Age 42 · centered on the optic disc · axial length (AL): 24 mm · 30-degree field of view · color fundus image · non-mydriatic · corneal thickness 534 µm · acquired with a Topcon TRC-NW400 — 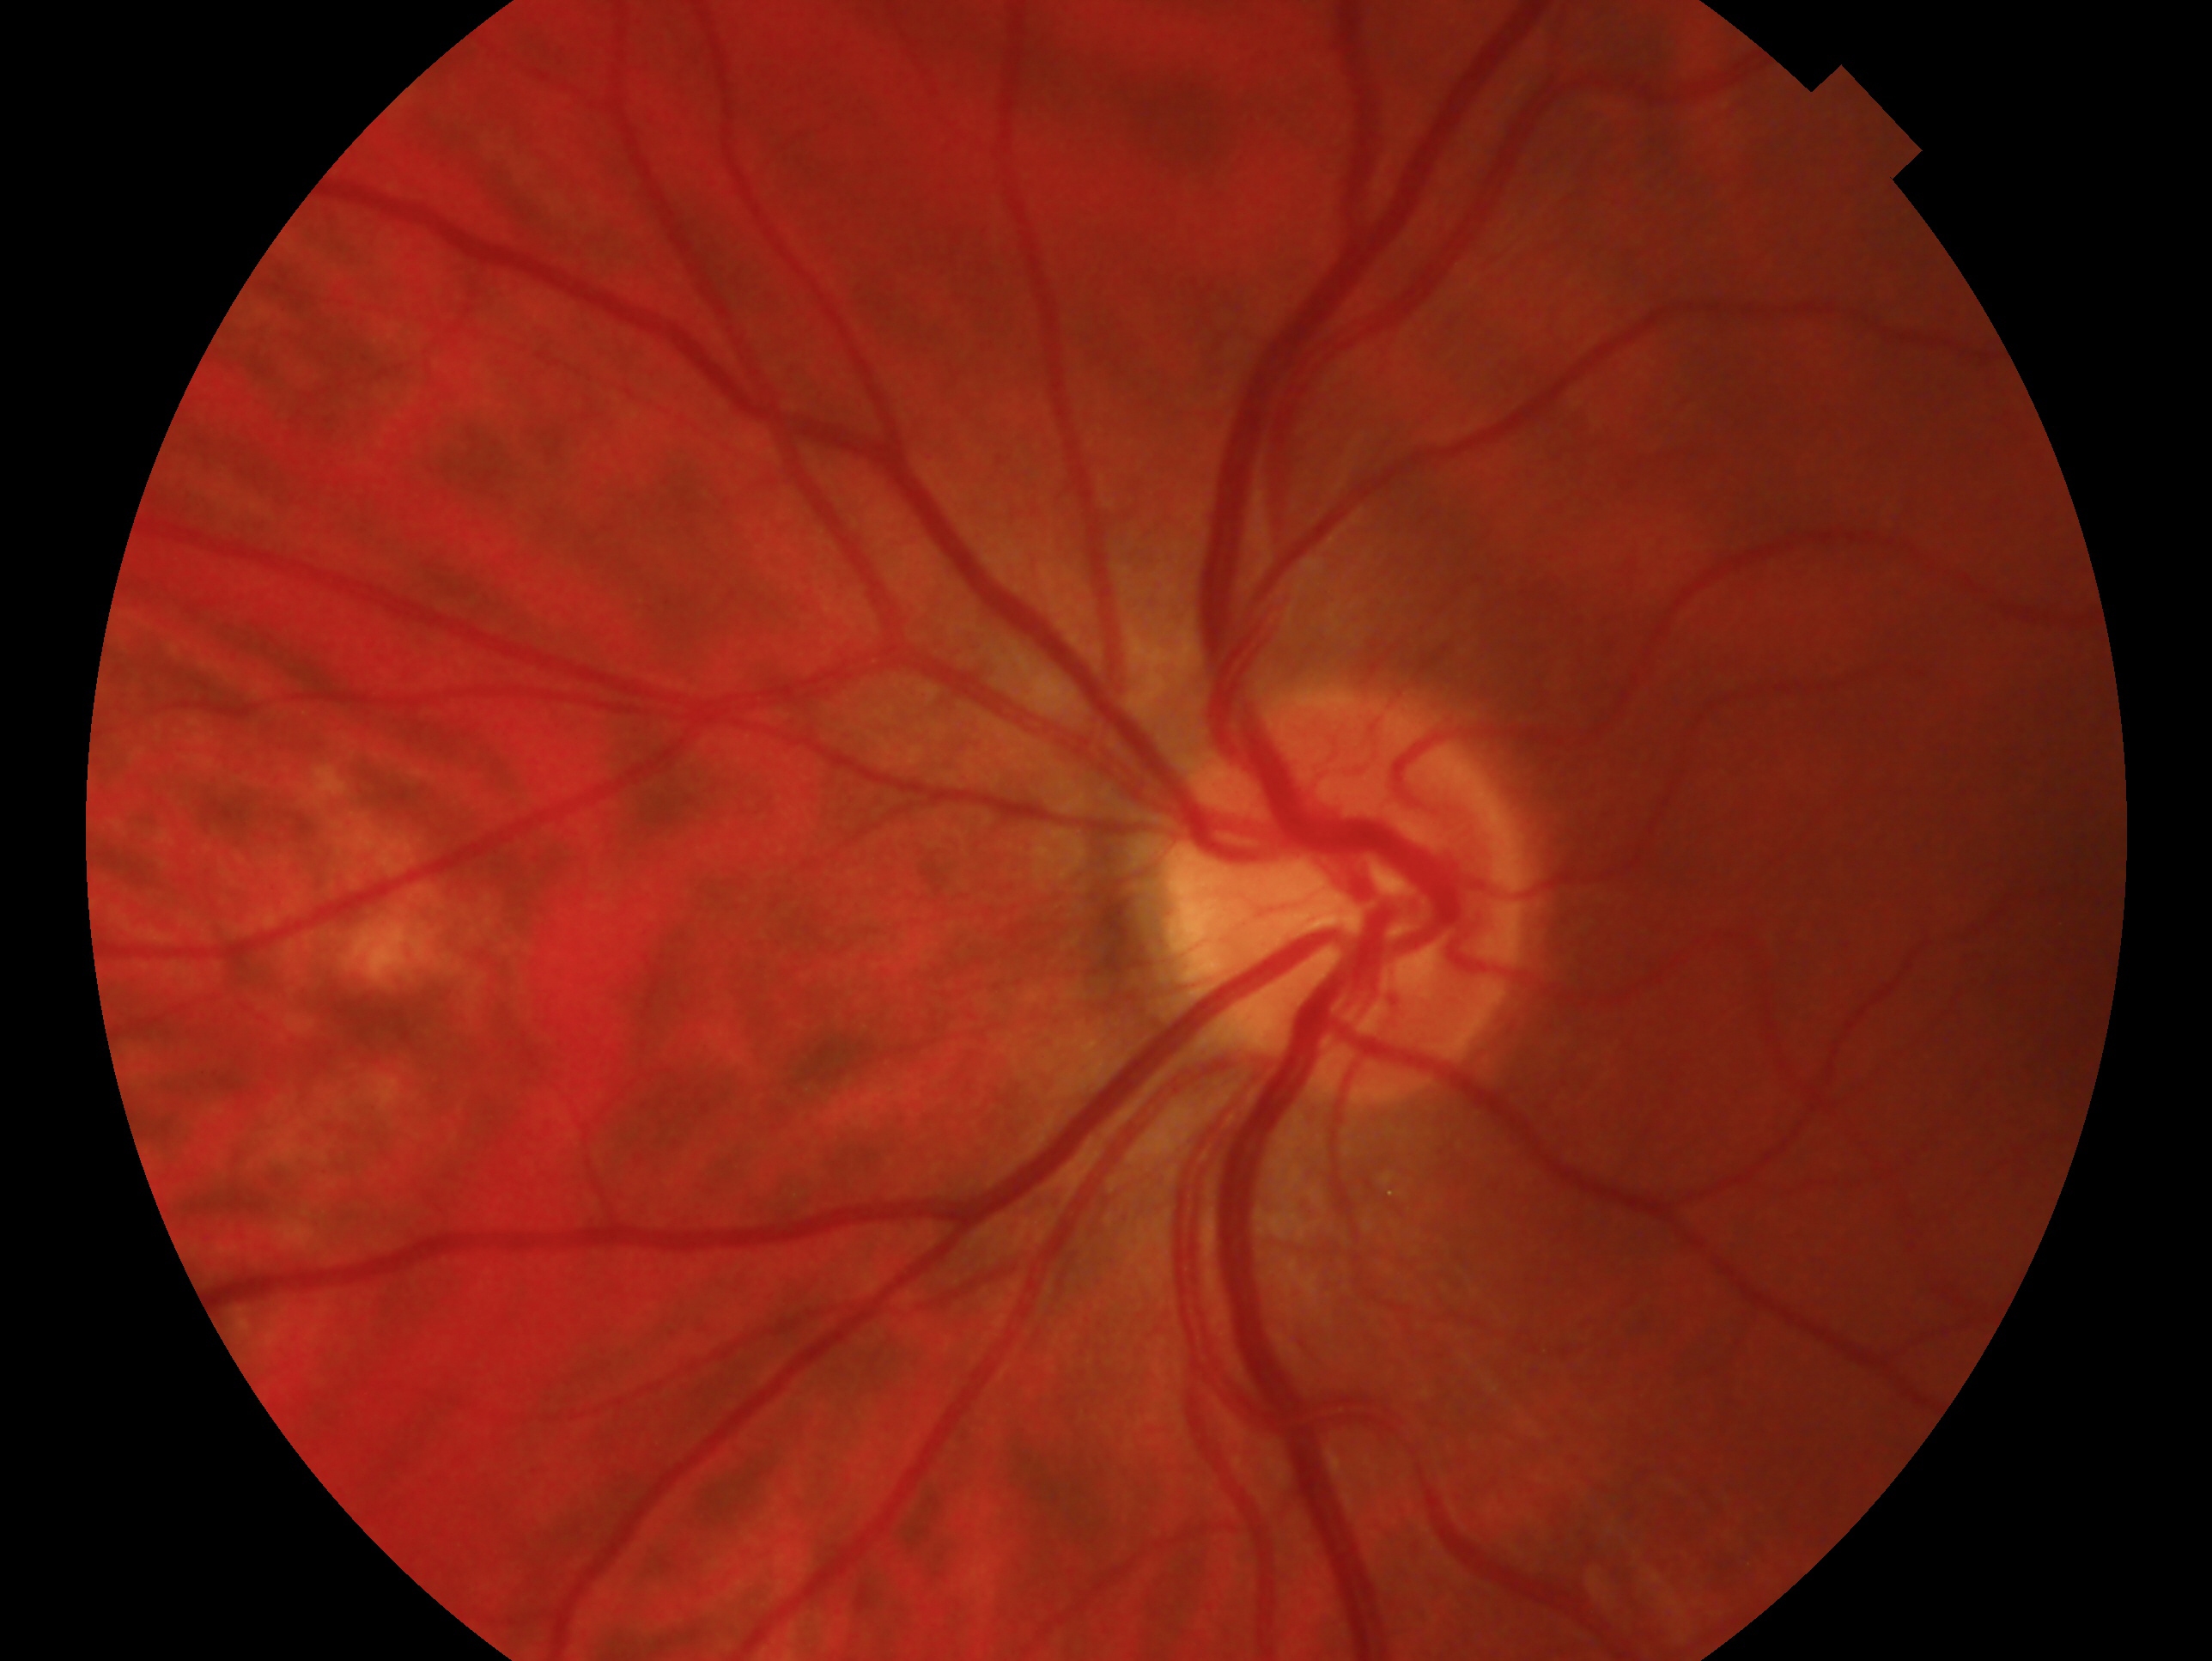
Glaucoma diagnosis: no signs of glaucoma.
This is the oculus sinister.